Image size 2352x1568 — 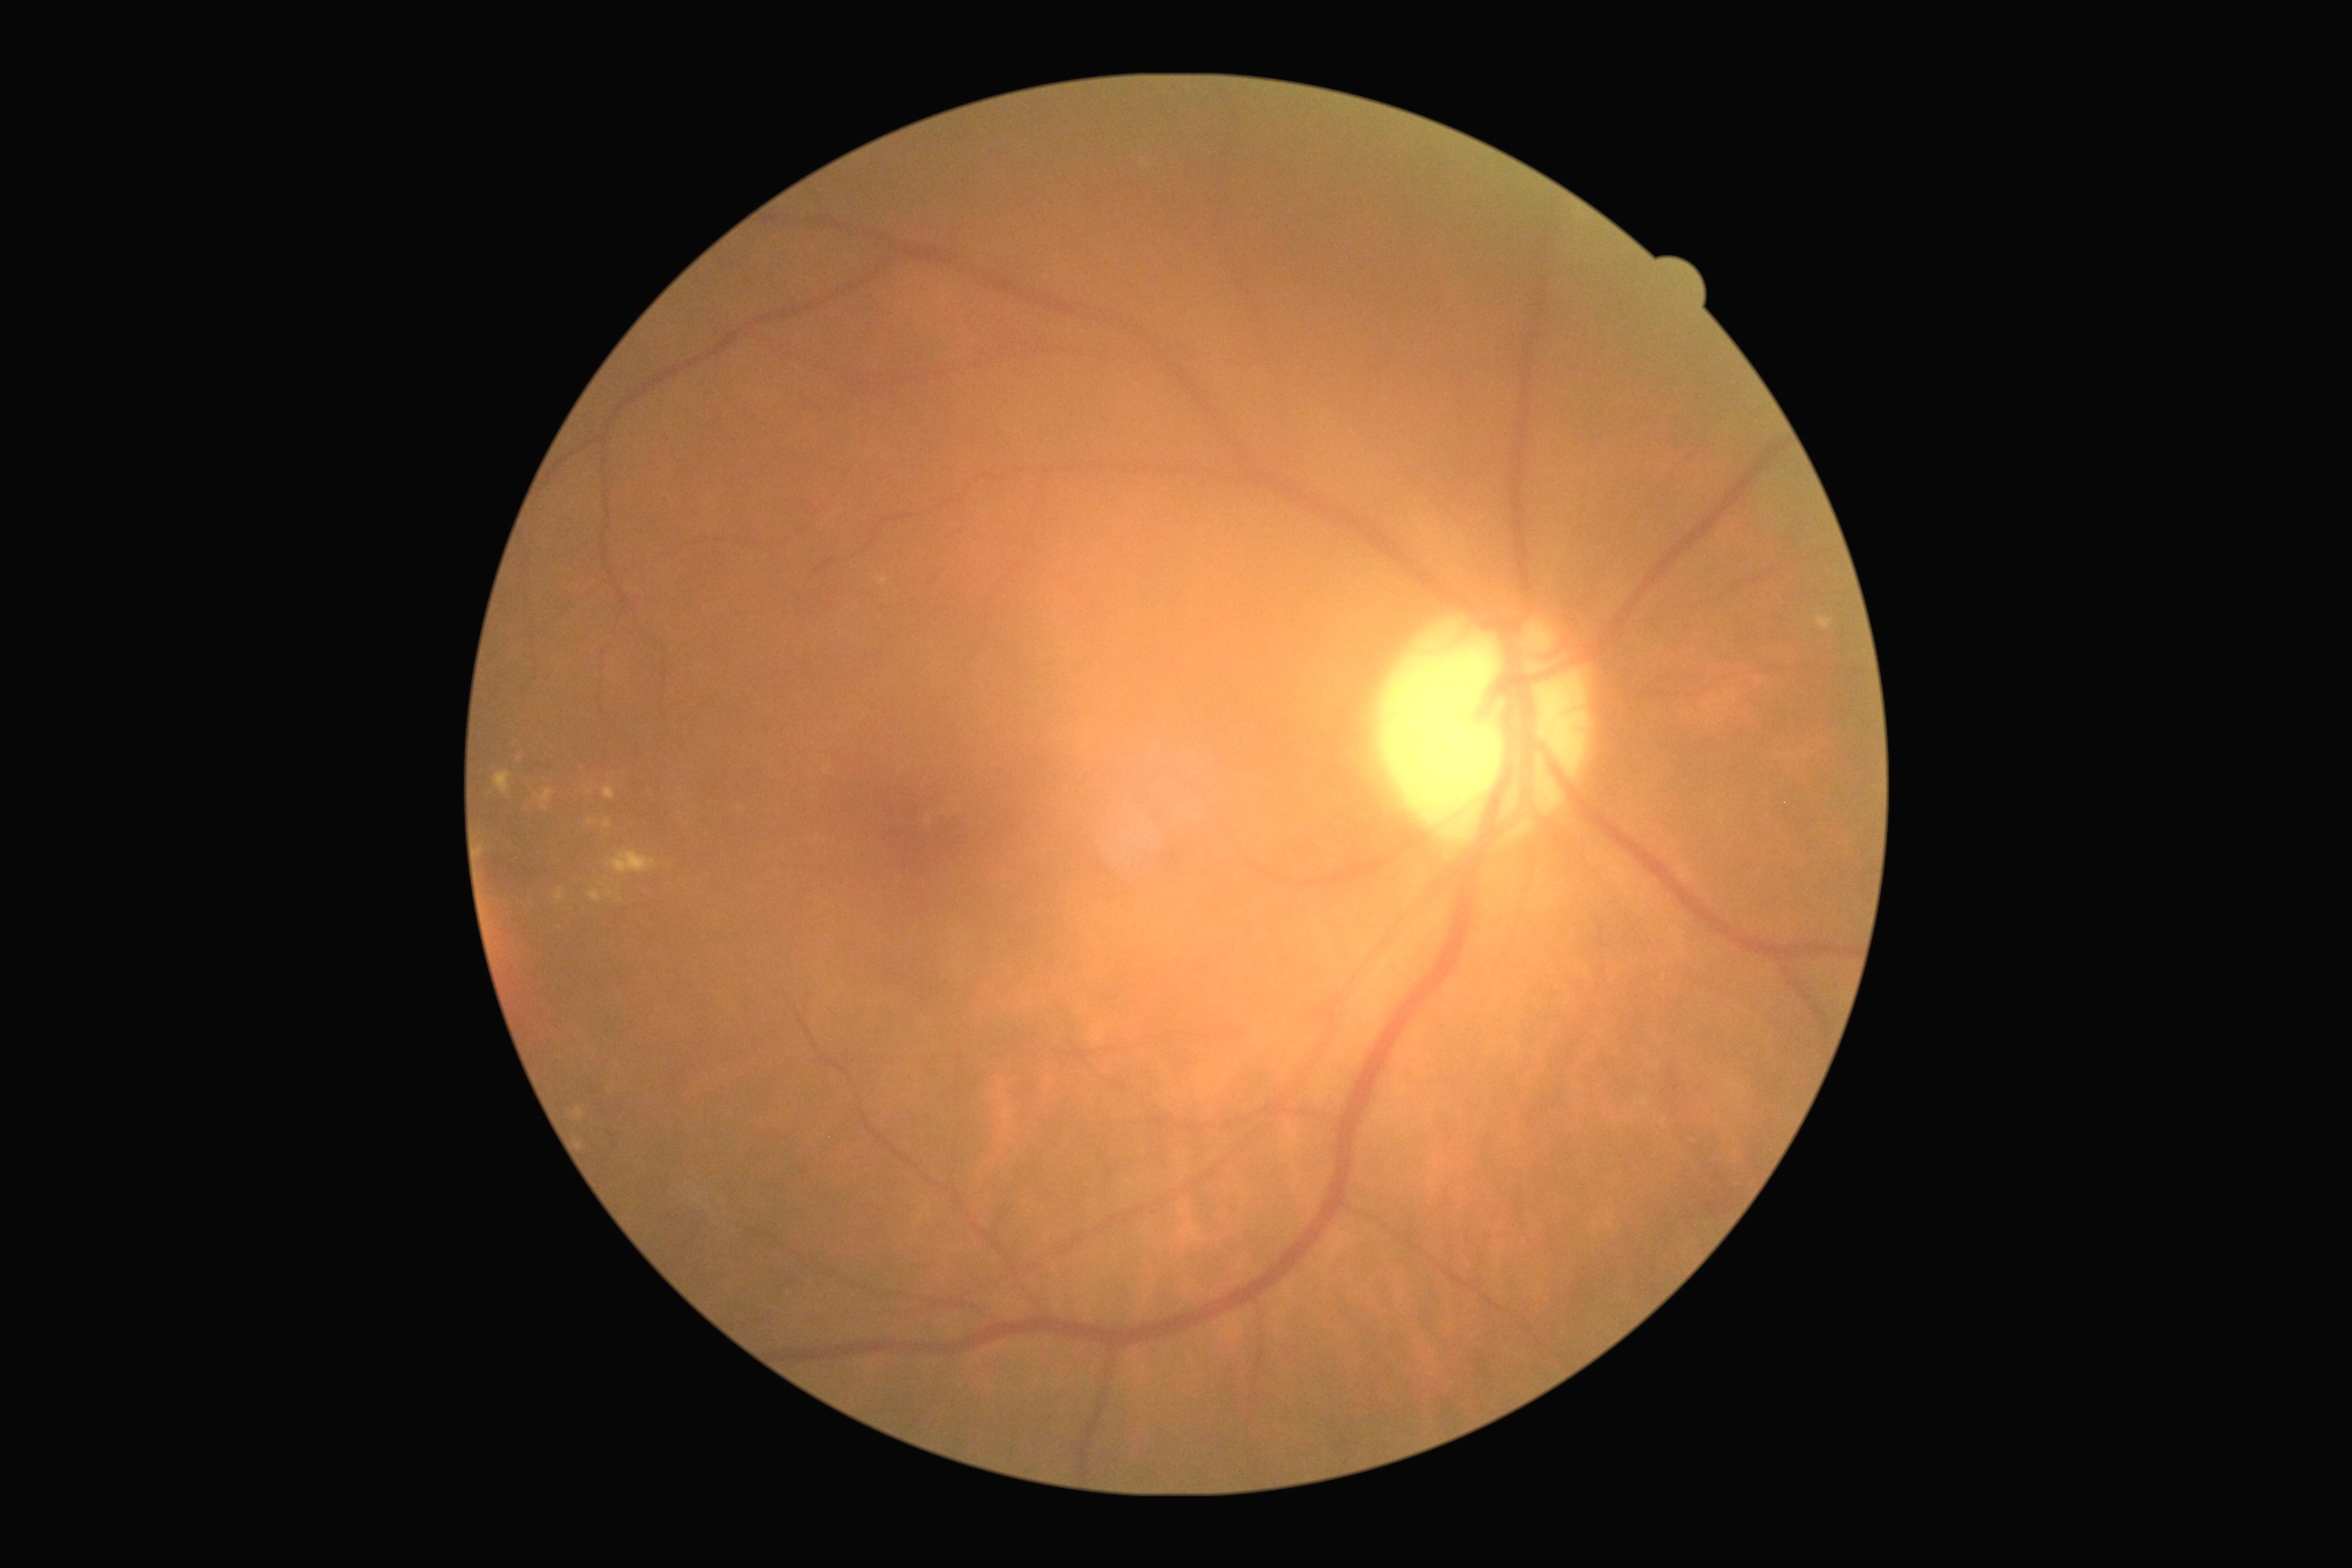

Diabetic retinopathy (DR): 2.